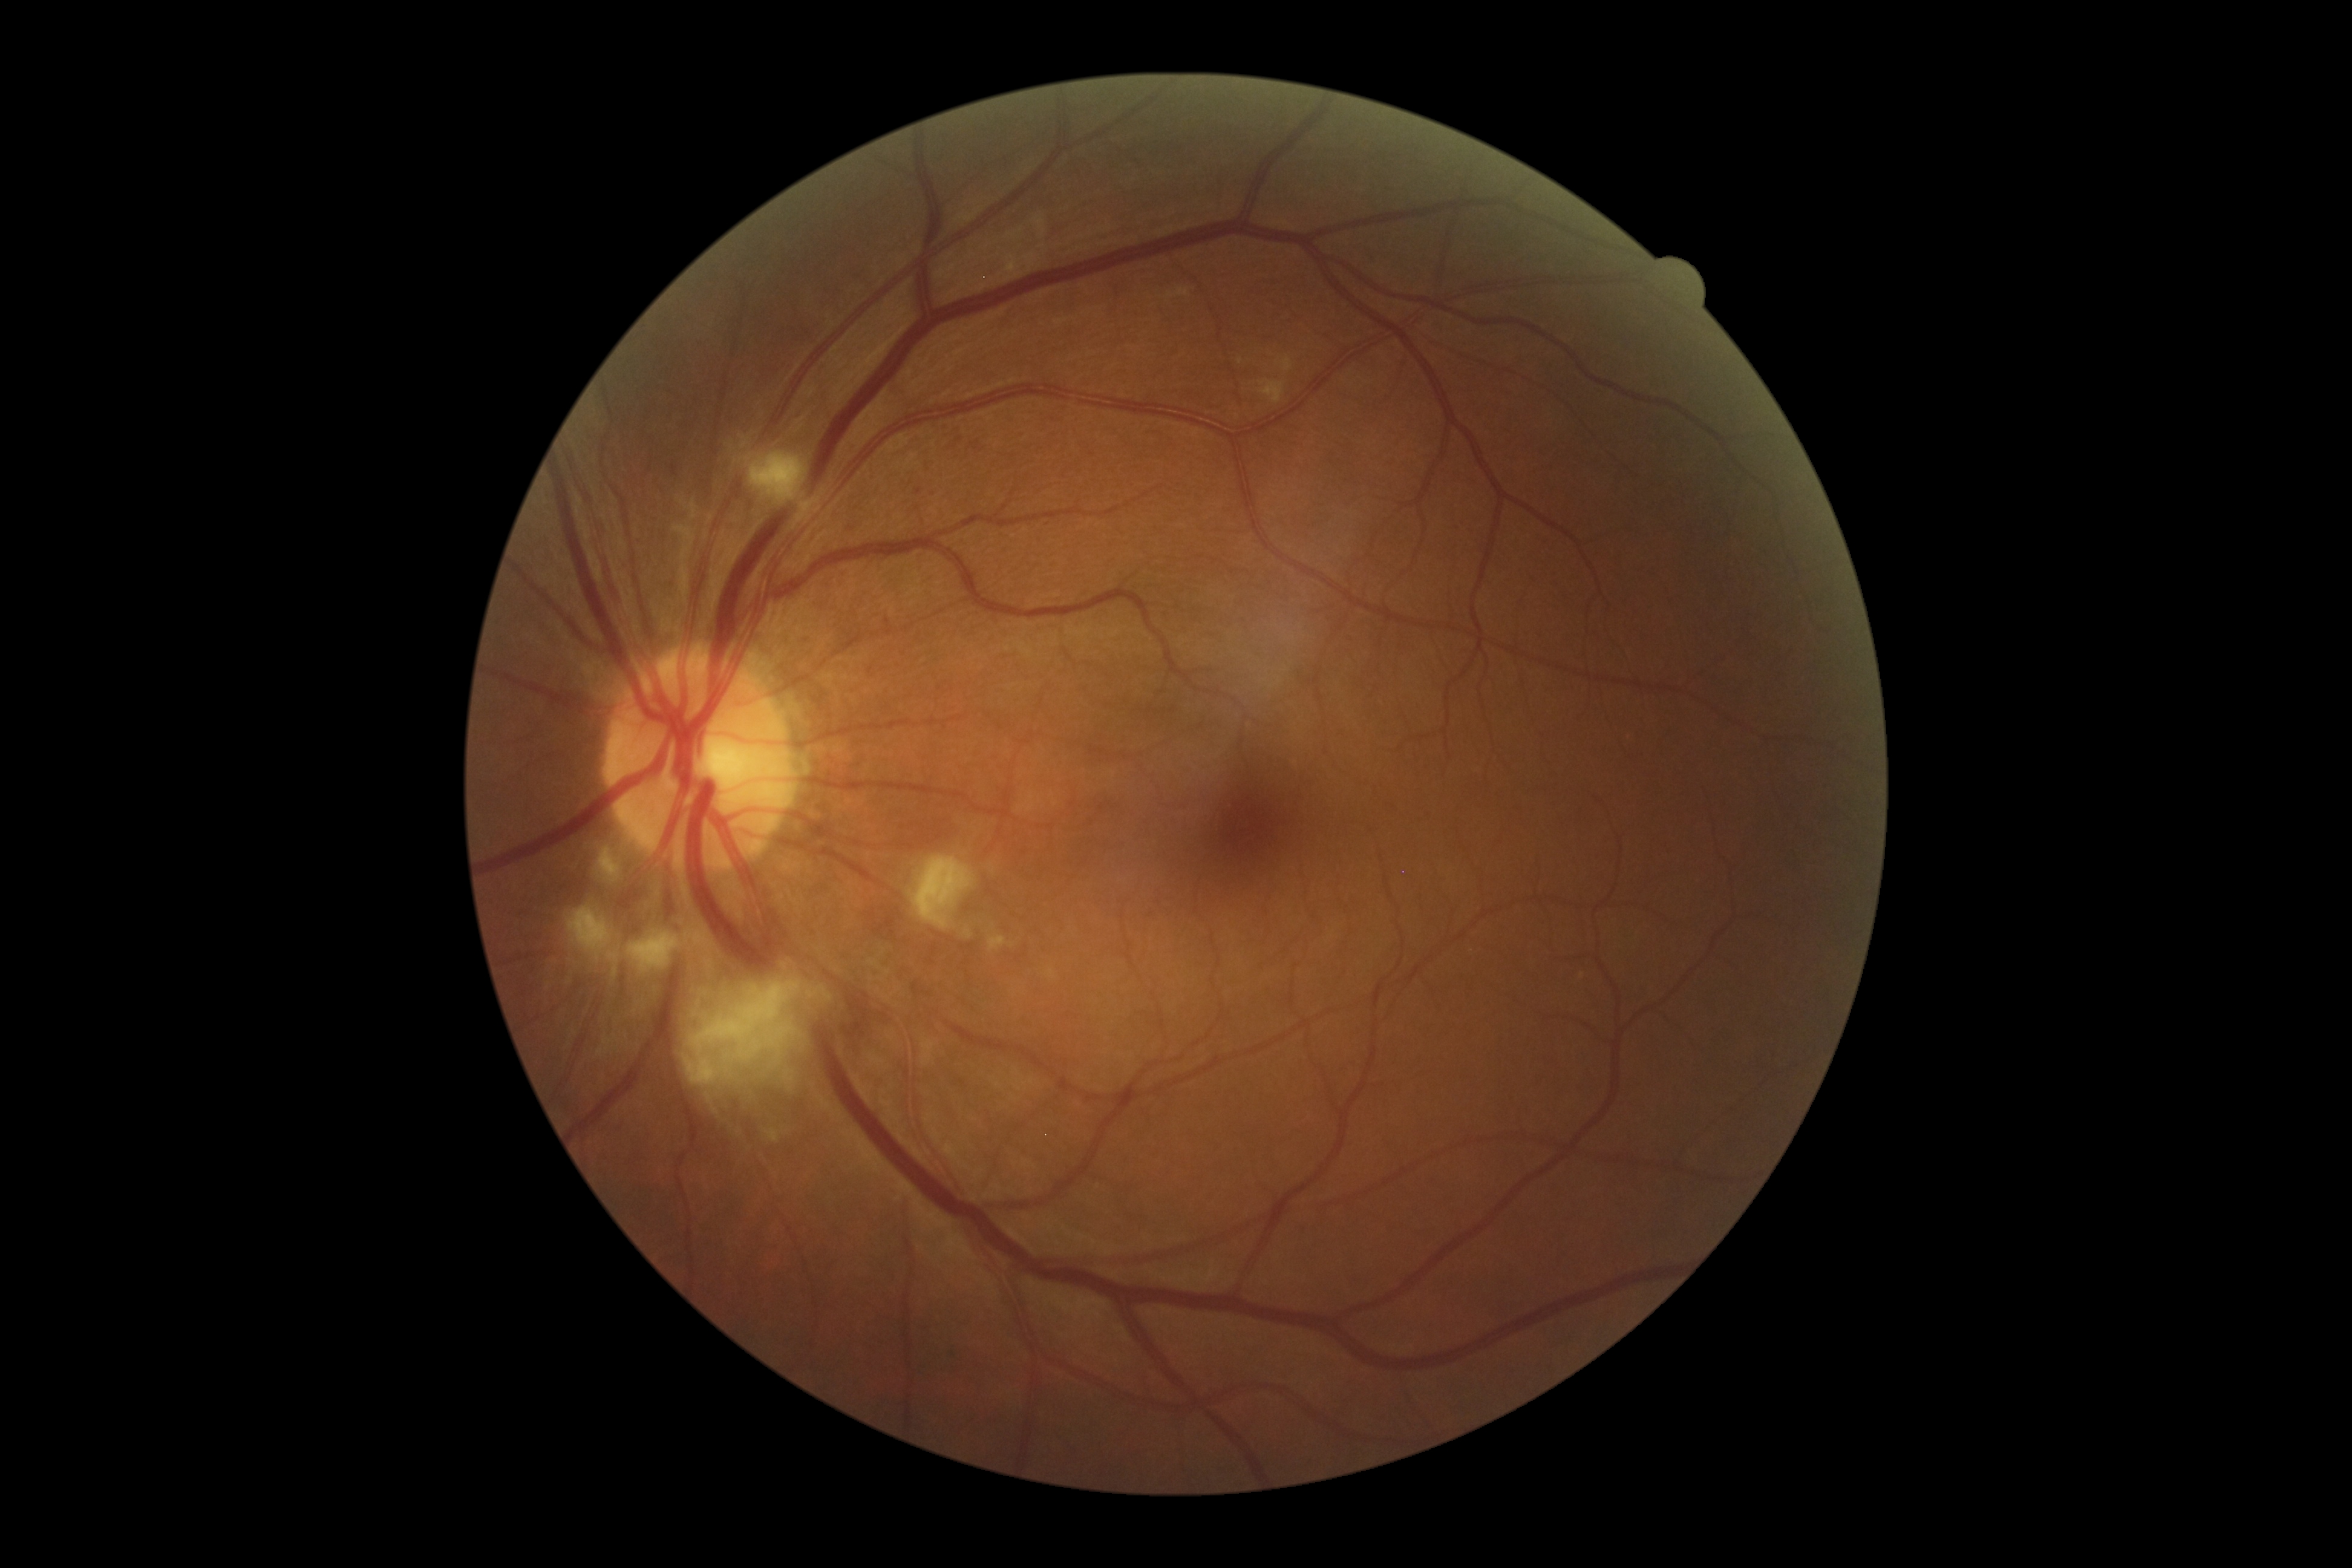

DR severity: 2/4.